Wide-field contact fundus photograph of an infant — 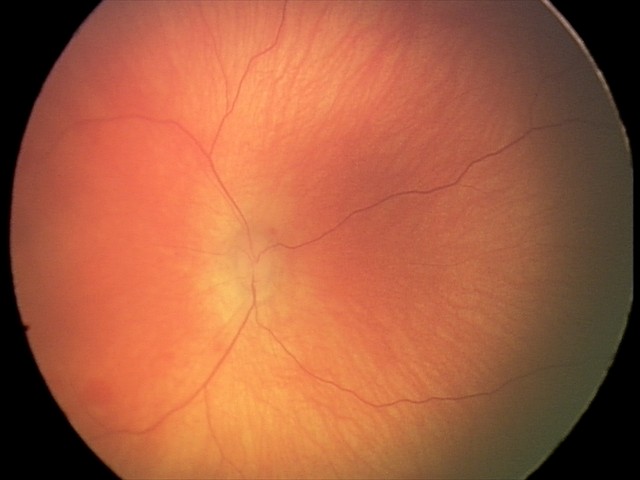 Screening diagnosis = retinal hemorrhages.